Nonmydriatic, color fundus image
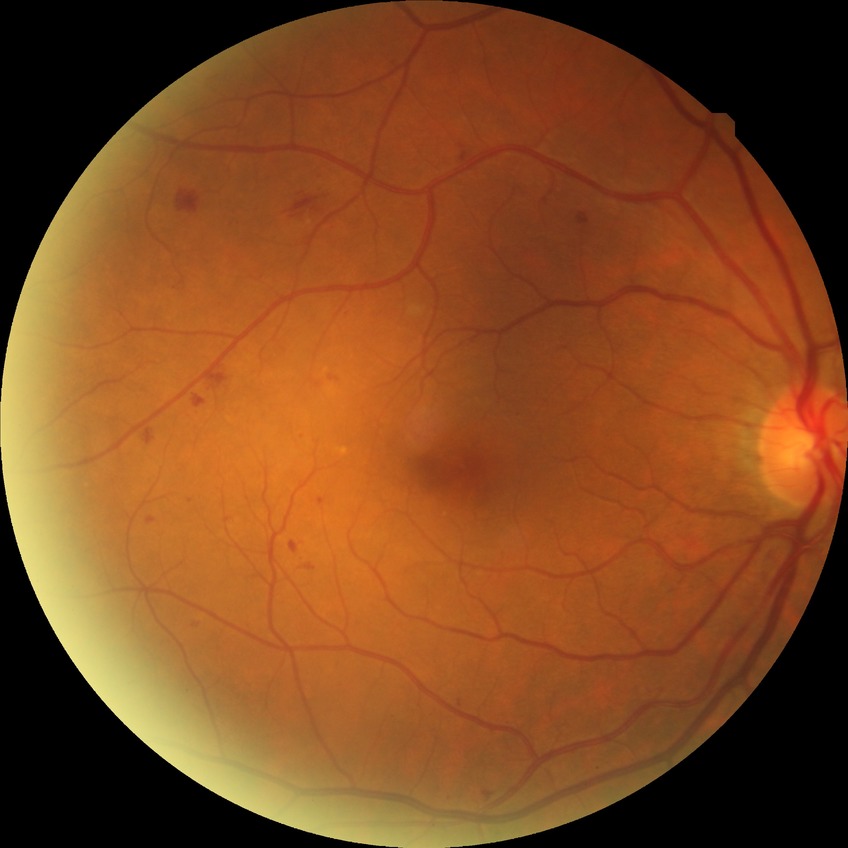
Diabetic retinopathy (DR): simple diabetic retinopathy (SDR).